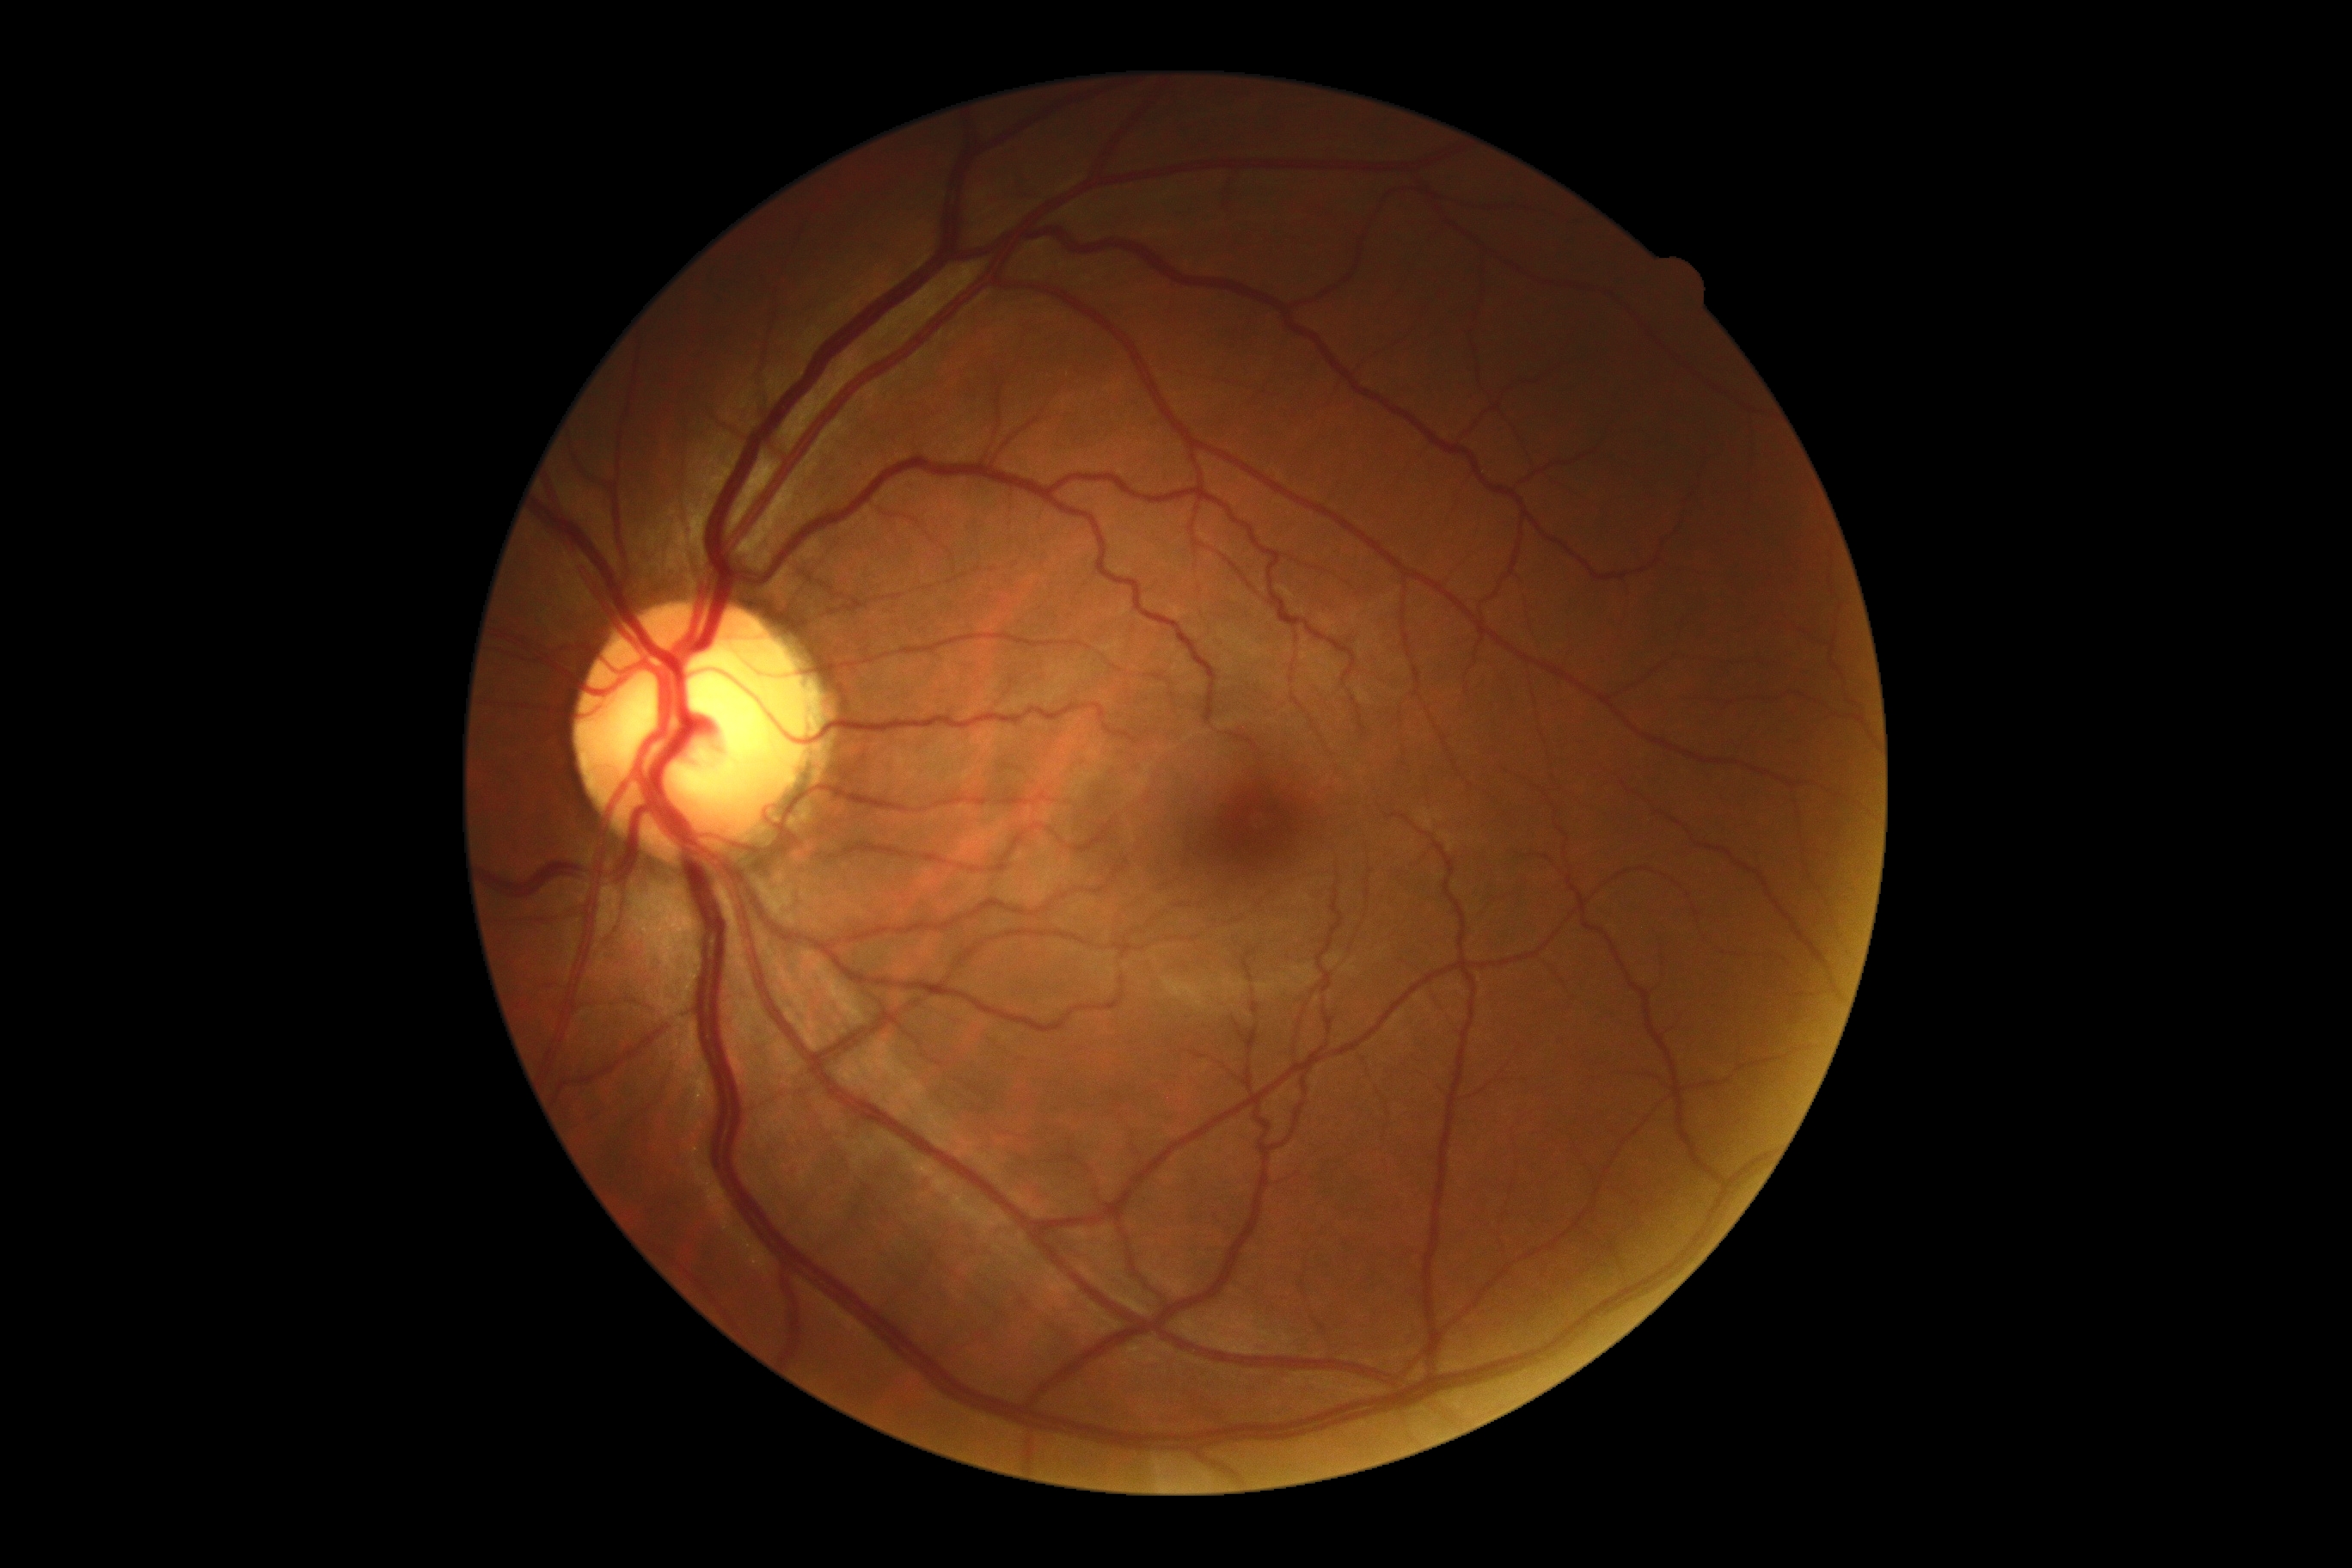 DR grade is 0 — no visible signs of diabetic retinopathy. No signs of diabetic retinopathy.